1932 by 1910 pixels.
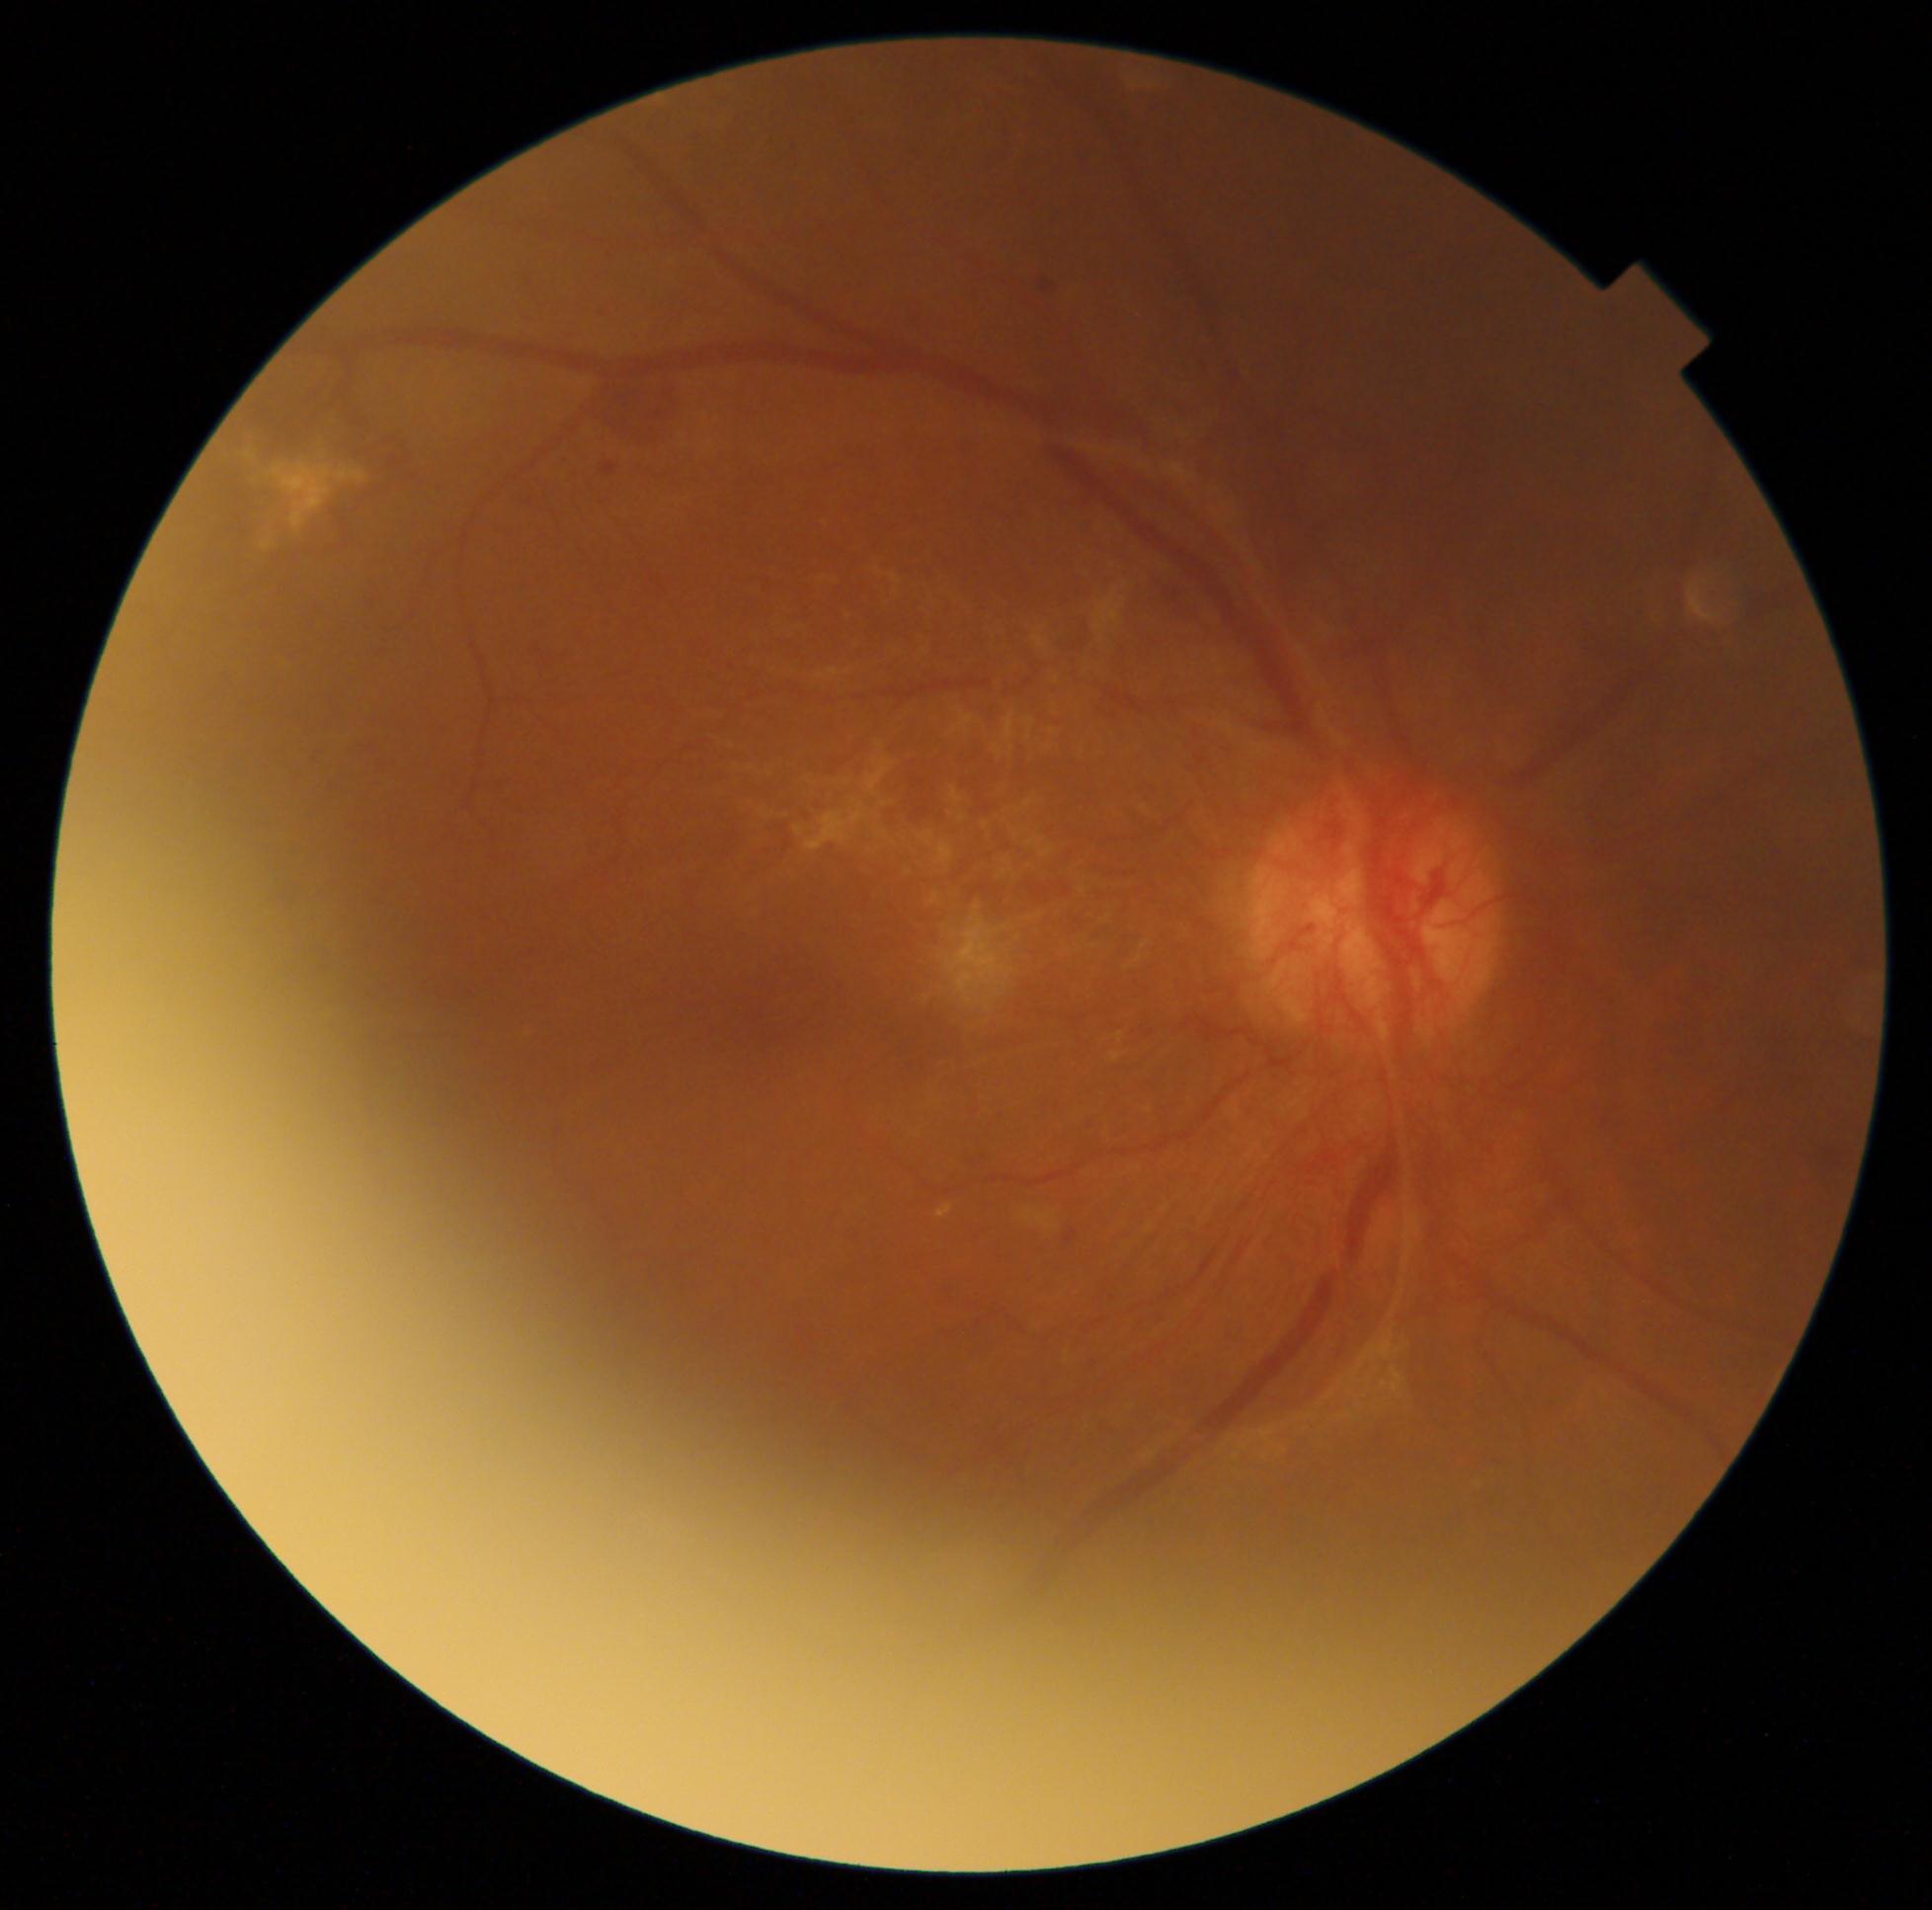
The retinopathy is classified as proliferative diabetic retinopathy. Diabetic retinopathy (DR) is grade 4 (PDR).